Color fundus image: 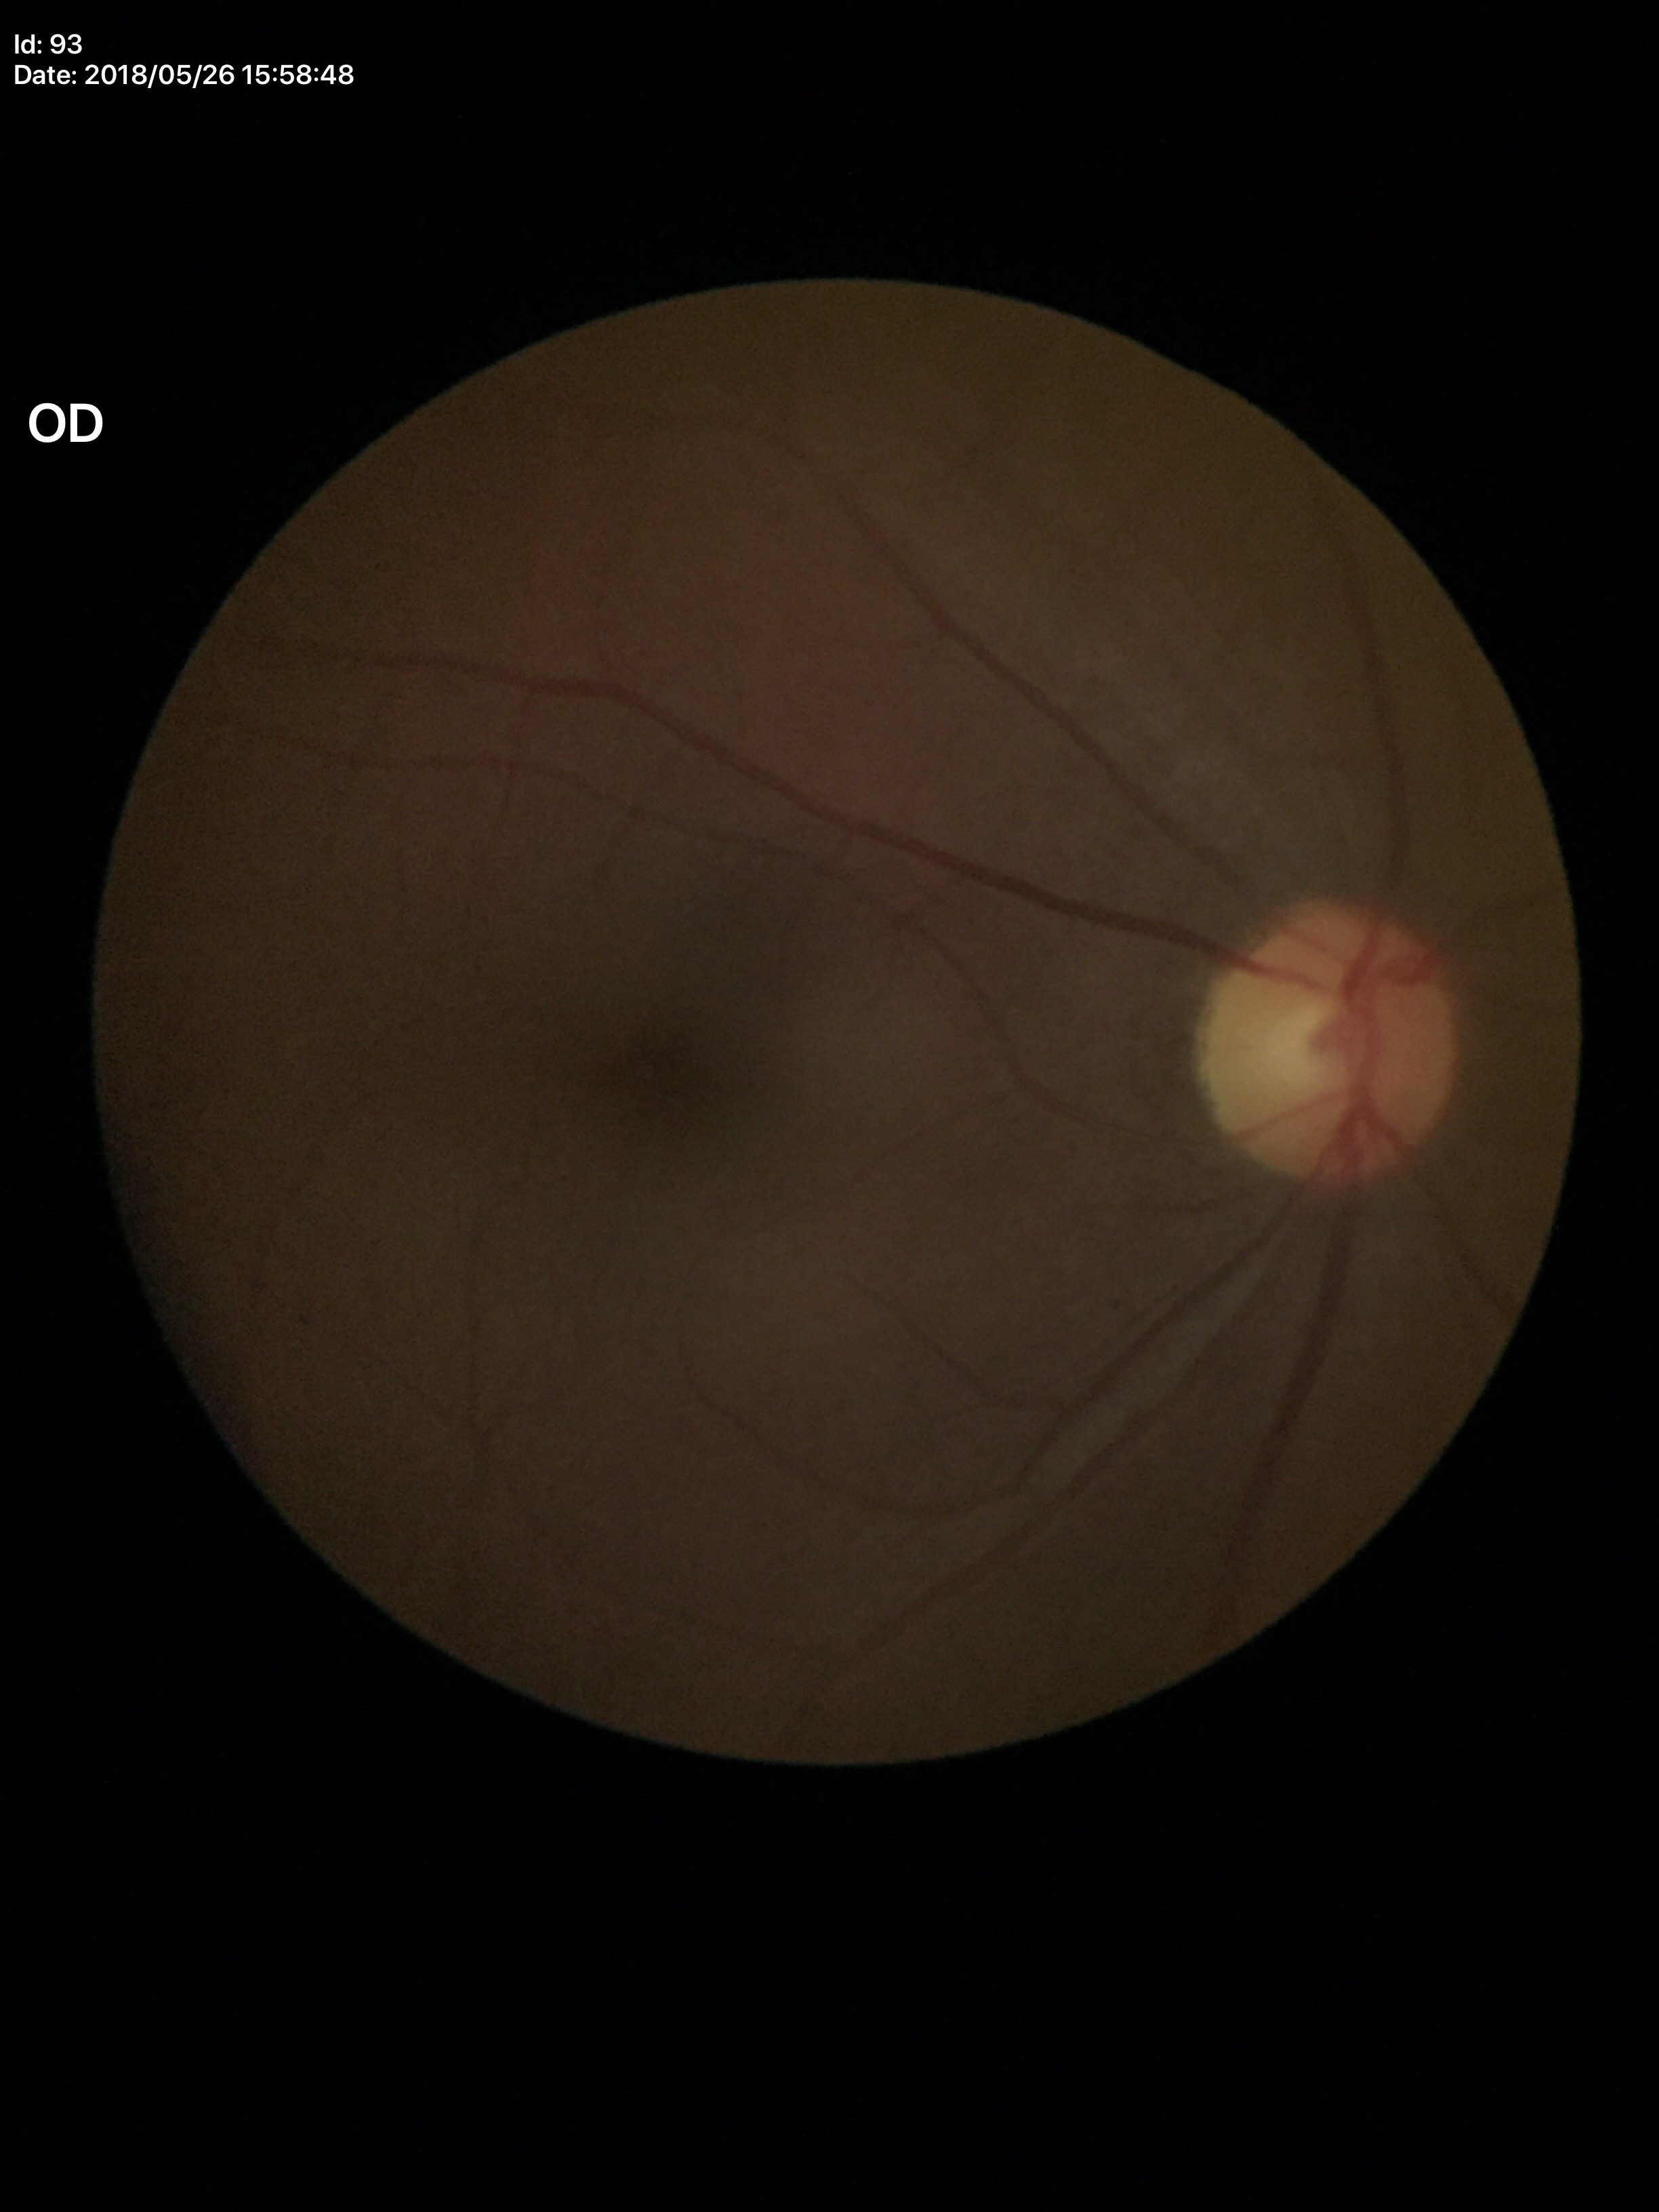 Glaucoma screening=negative (all 5 graders called normal) | vertical cup-to-disc ratio (VCDR)=0.48